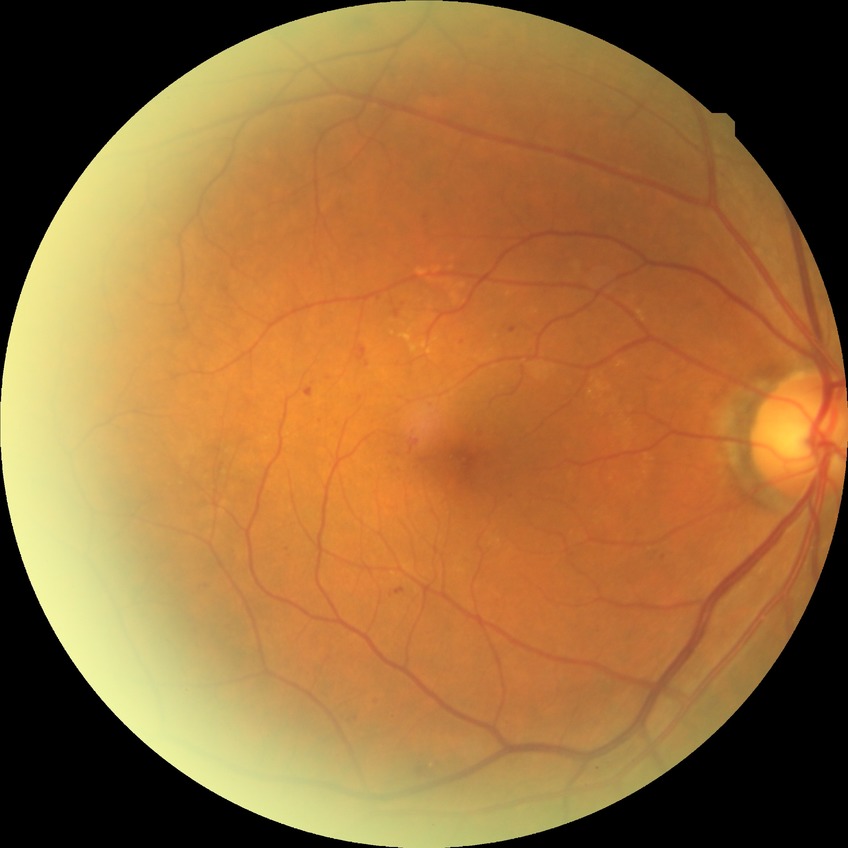 Diabetic retinopathy severity is simple diabetic retinopathy.